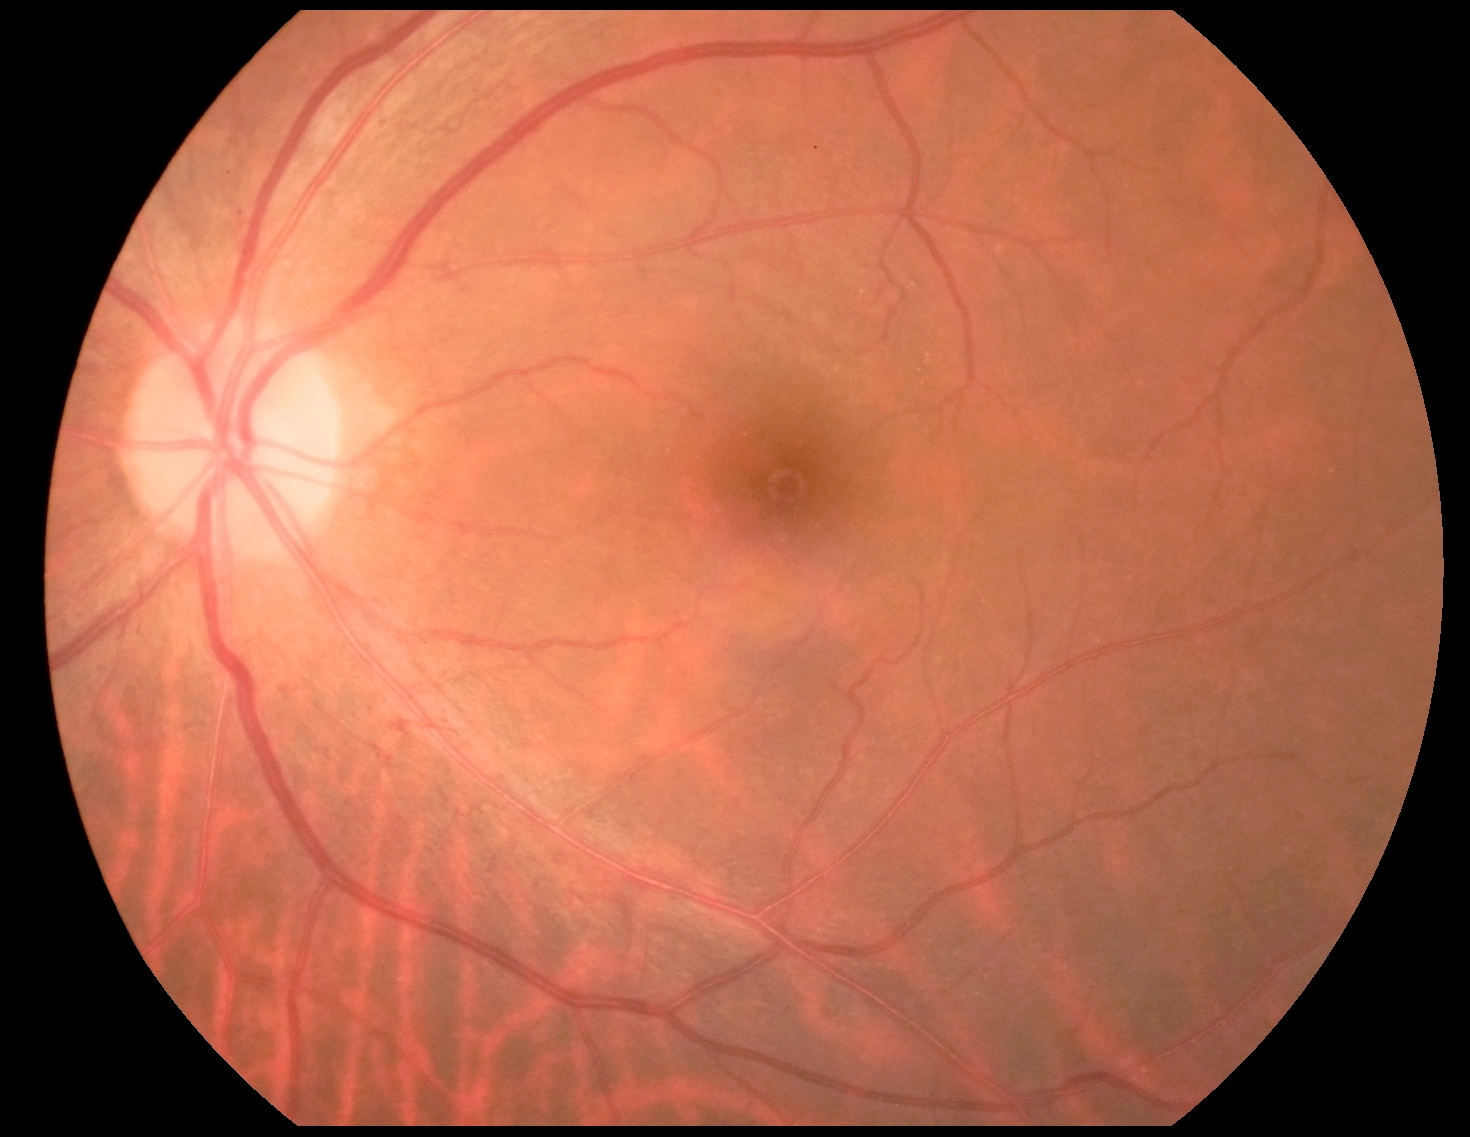

diabetic retinopathy grade: 1.